45° field of view:
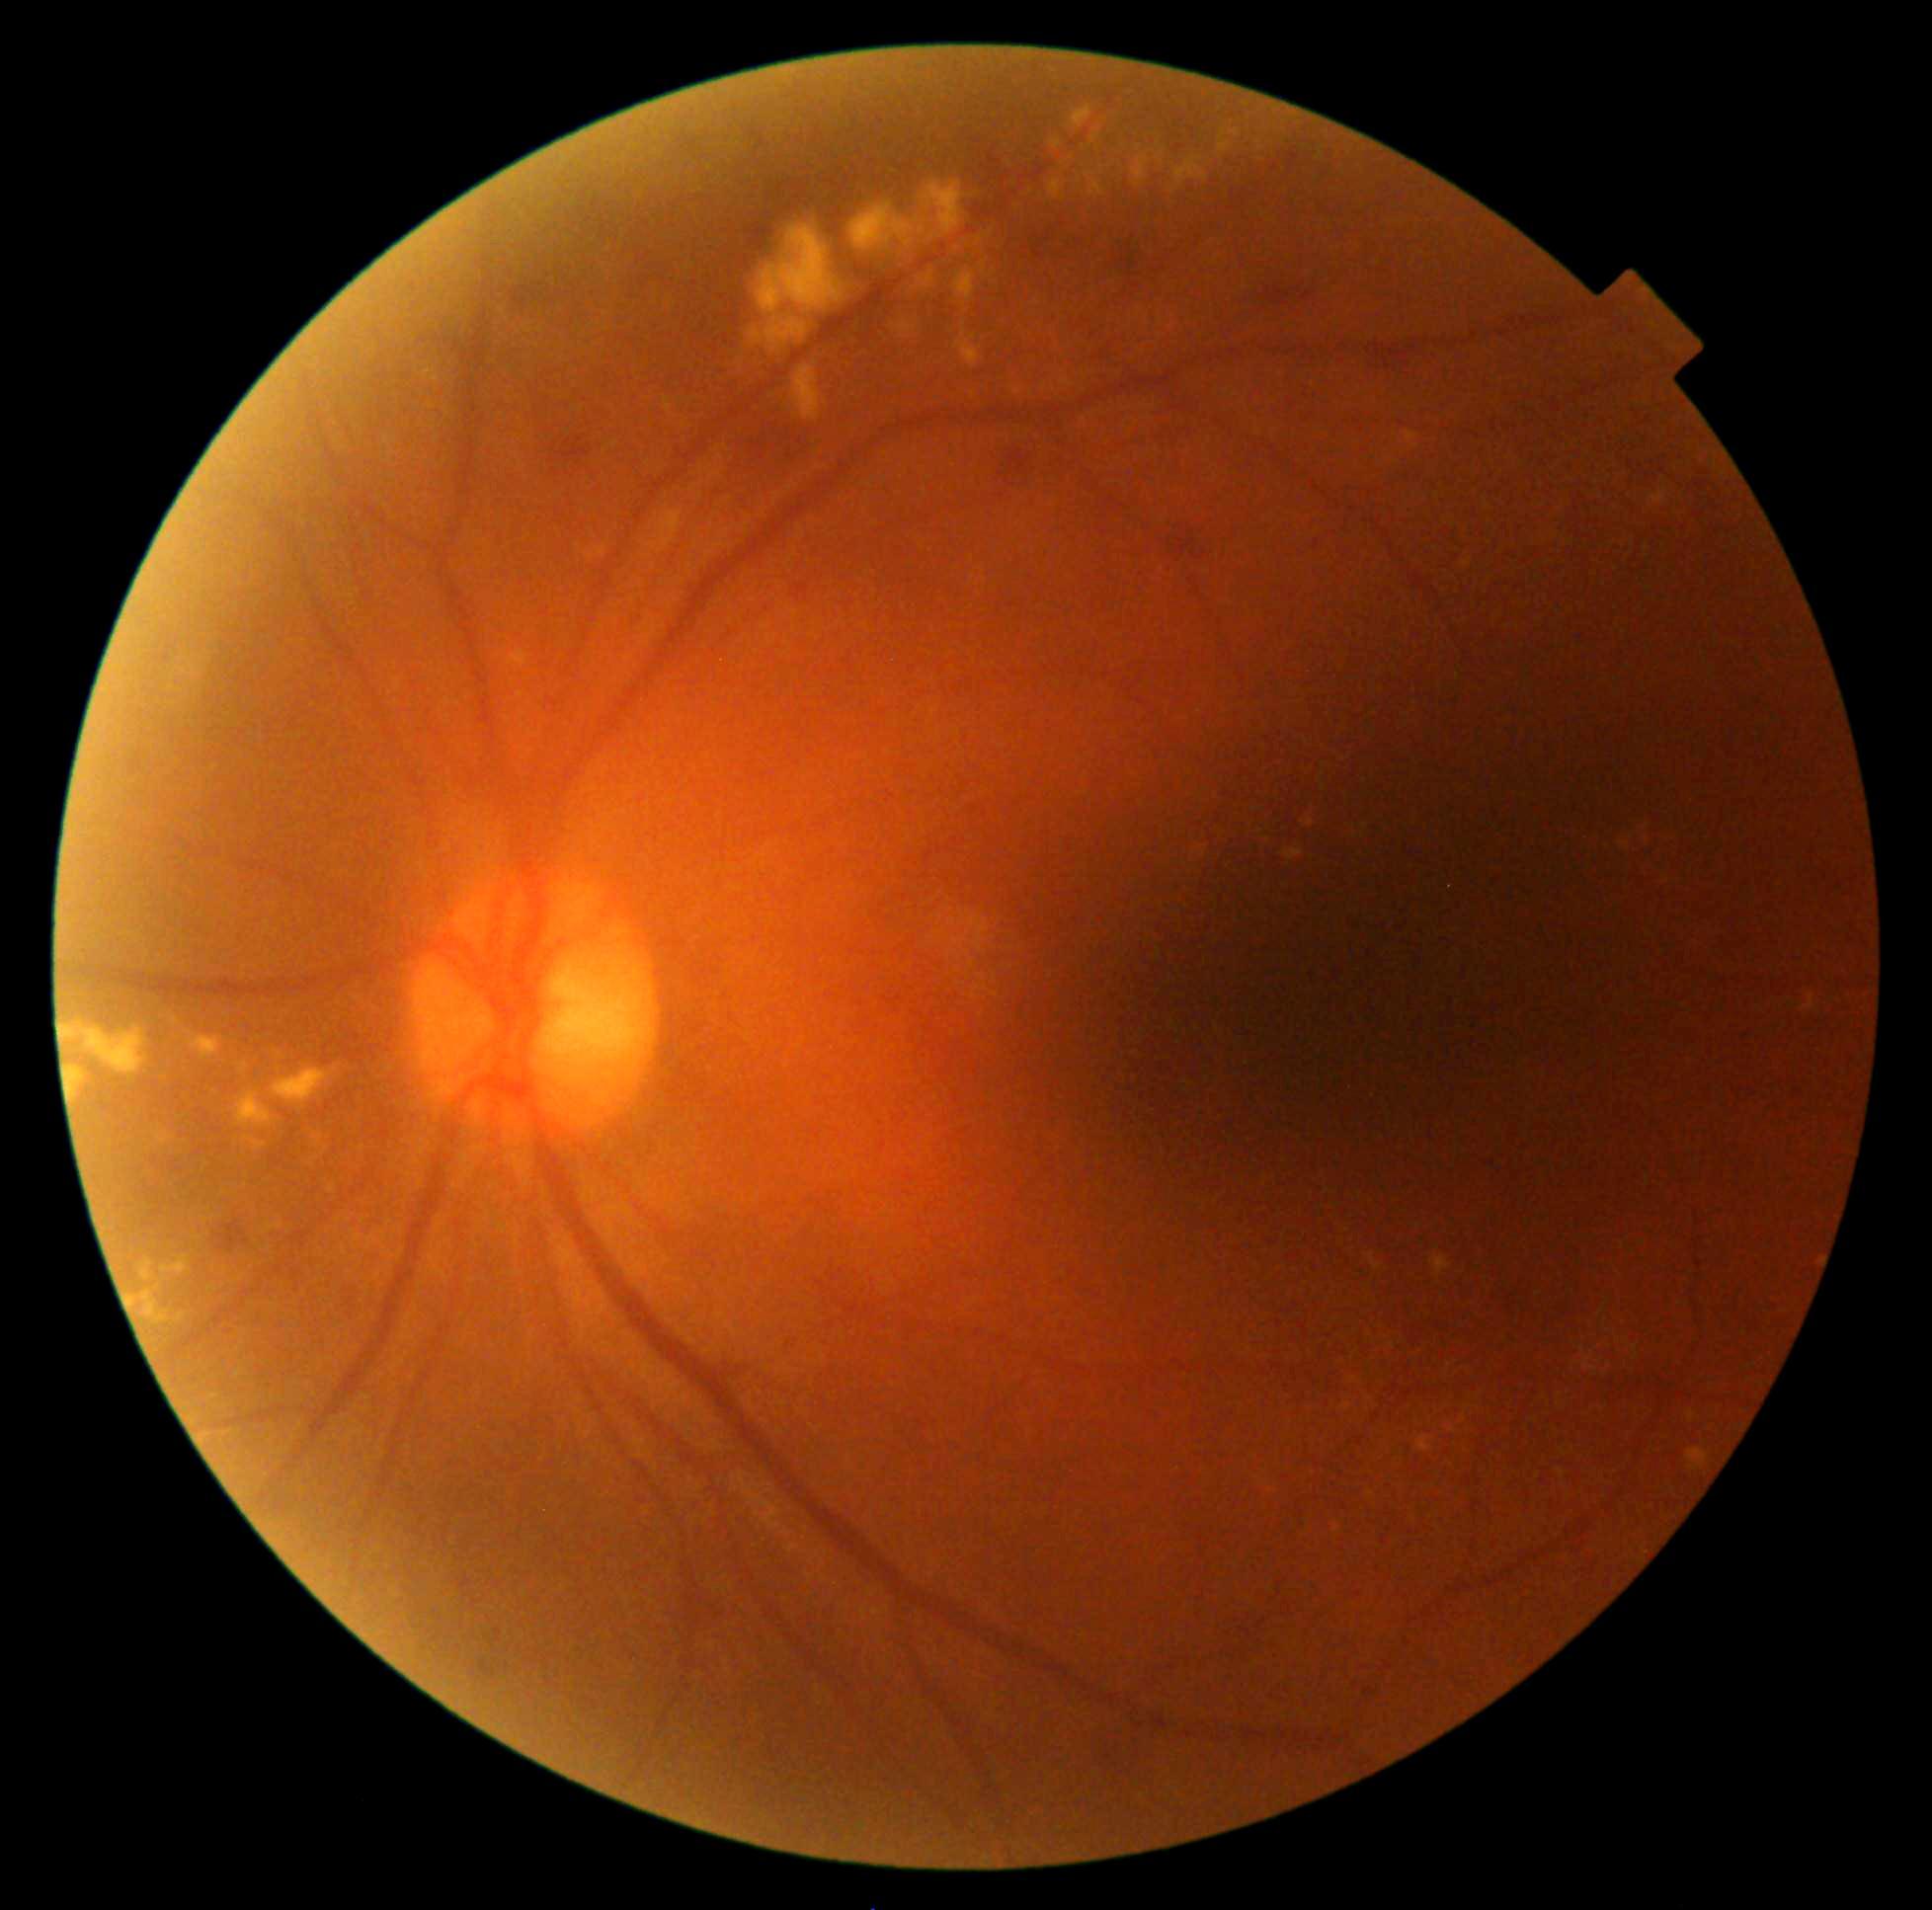
{"partial":true,"dr_grade":2,"lesions":{"ex":[[1335,1525,1340,1533],[919,274,934,288],[1092,134,1101,143],[894,320,917,340],[190,1036,220,1061],[1462,1405,1471,1423],[161,1255,188,1275],[598,547,607,557],[649,512,683,554],[1462,561,1473,567],[919,181,965,243],[751,329,764,346],[141,1259,154,1281]],"ex_small":[[436,378],[1102,171],[1354,1379],[1031,393],[1393,1345]]}}